Diabetic retinopathy graded by the modified Davis classification: 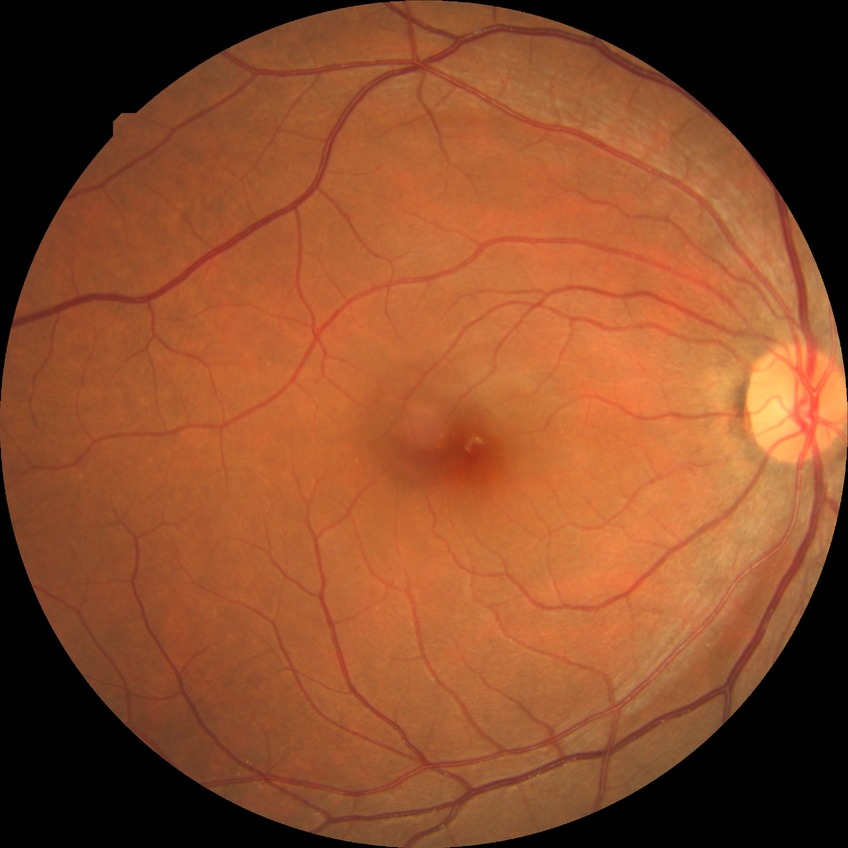

Diabetic retinopathy (DR) is NDR (no diabetic retinopathy).